Wide-field fundus photograph from neonatal ROP screening.
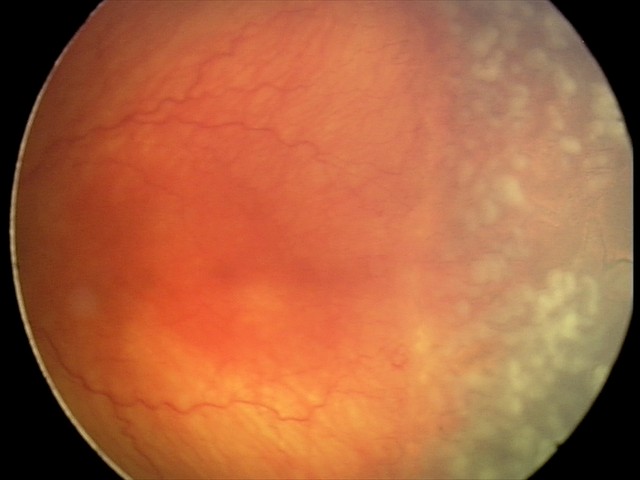

Screening series with aggressive retinopathy of prematurity (A-ROP). Plus disease present.